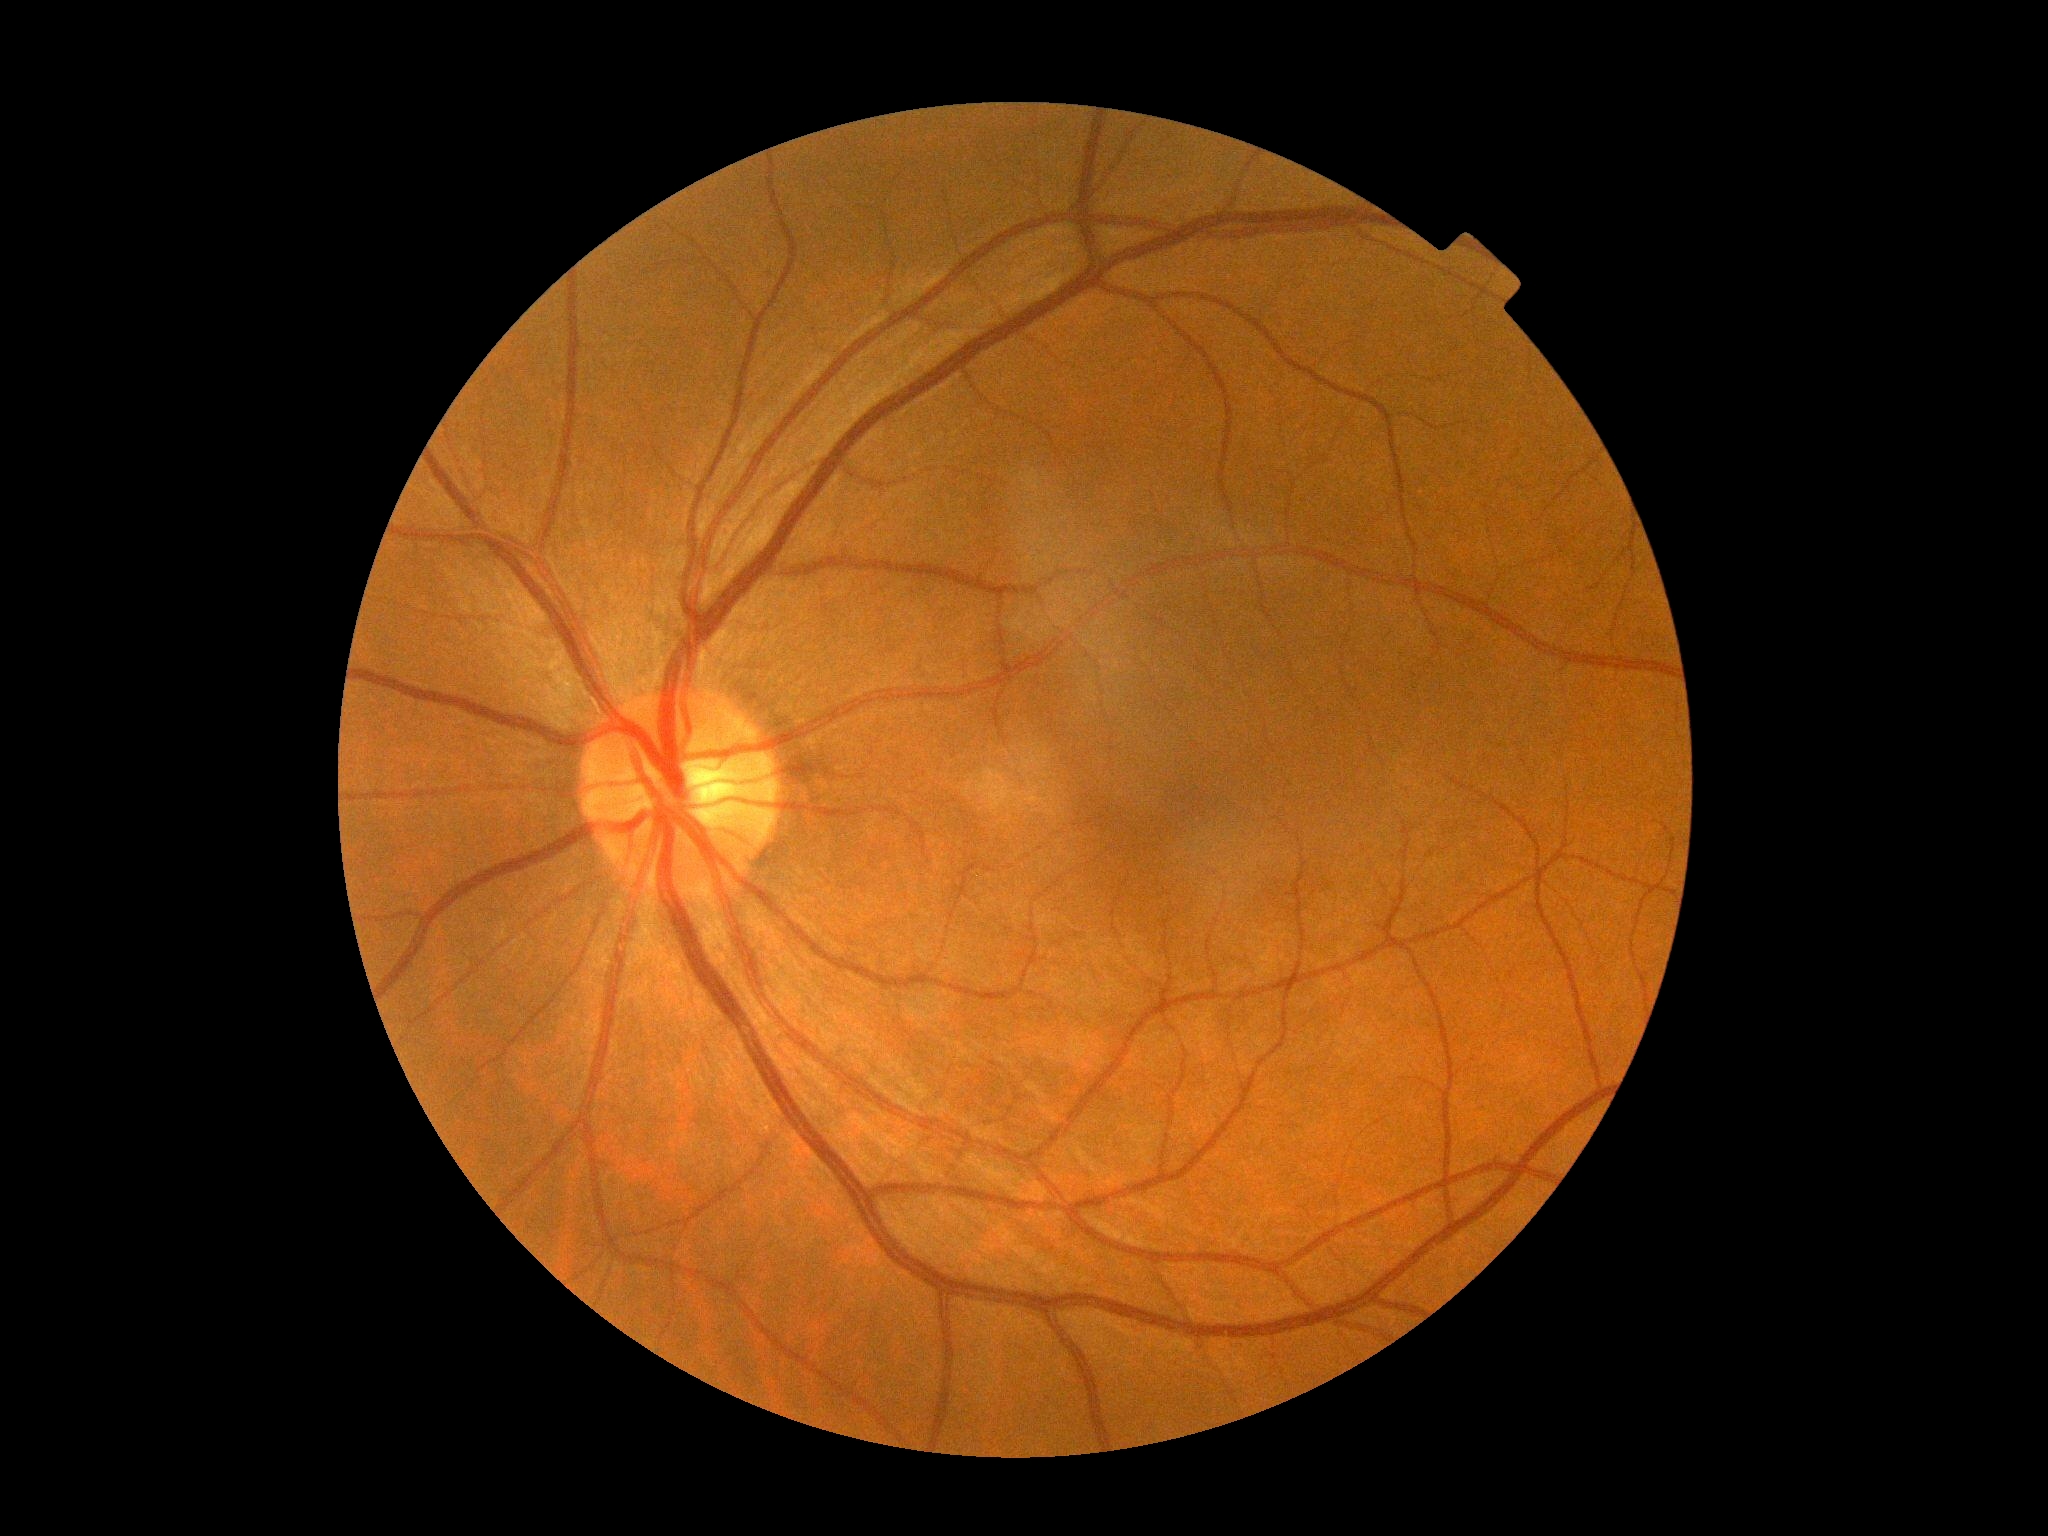

* DR — no apparent retinopathy (grade 0) — no visible signs of diabetic retinopathy